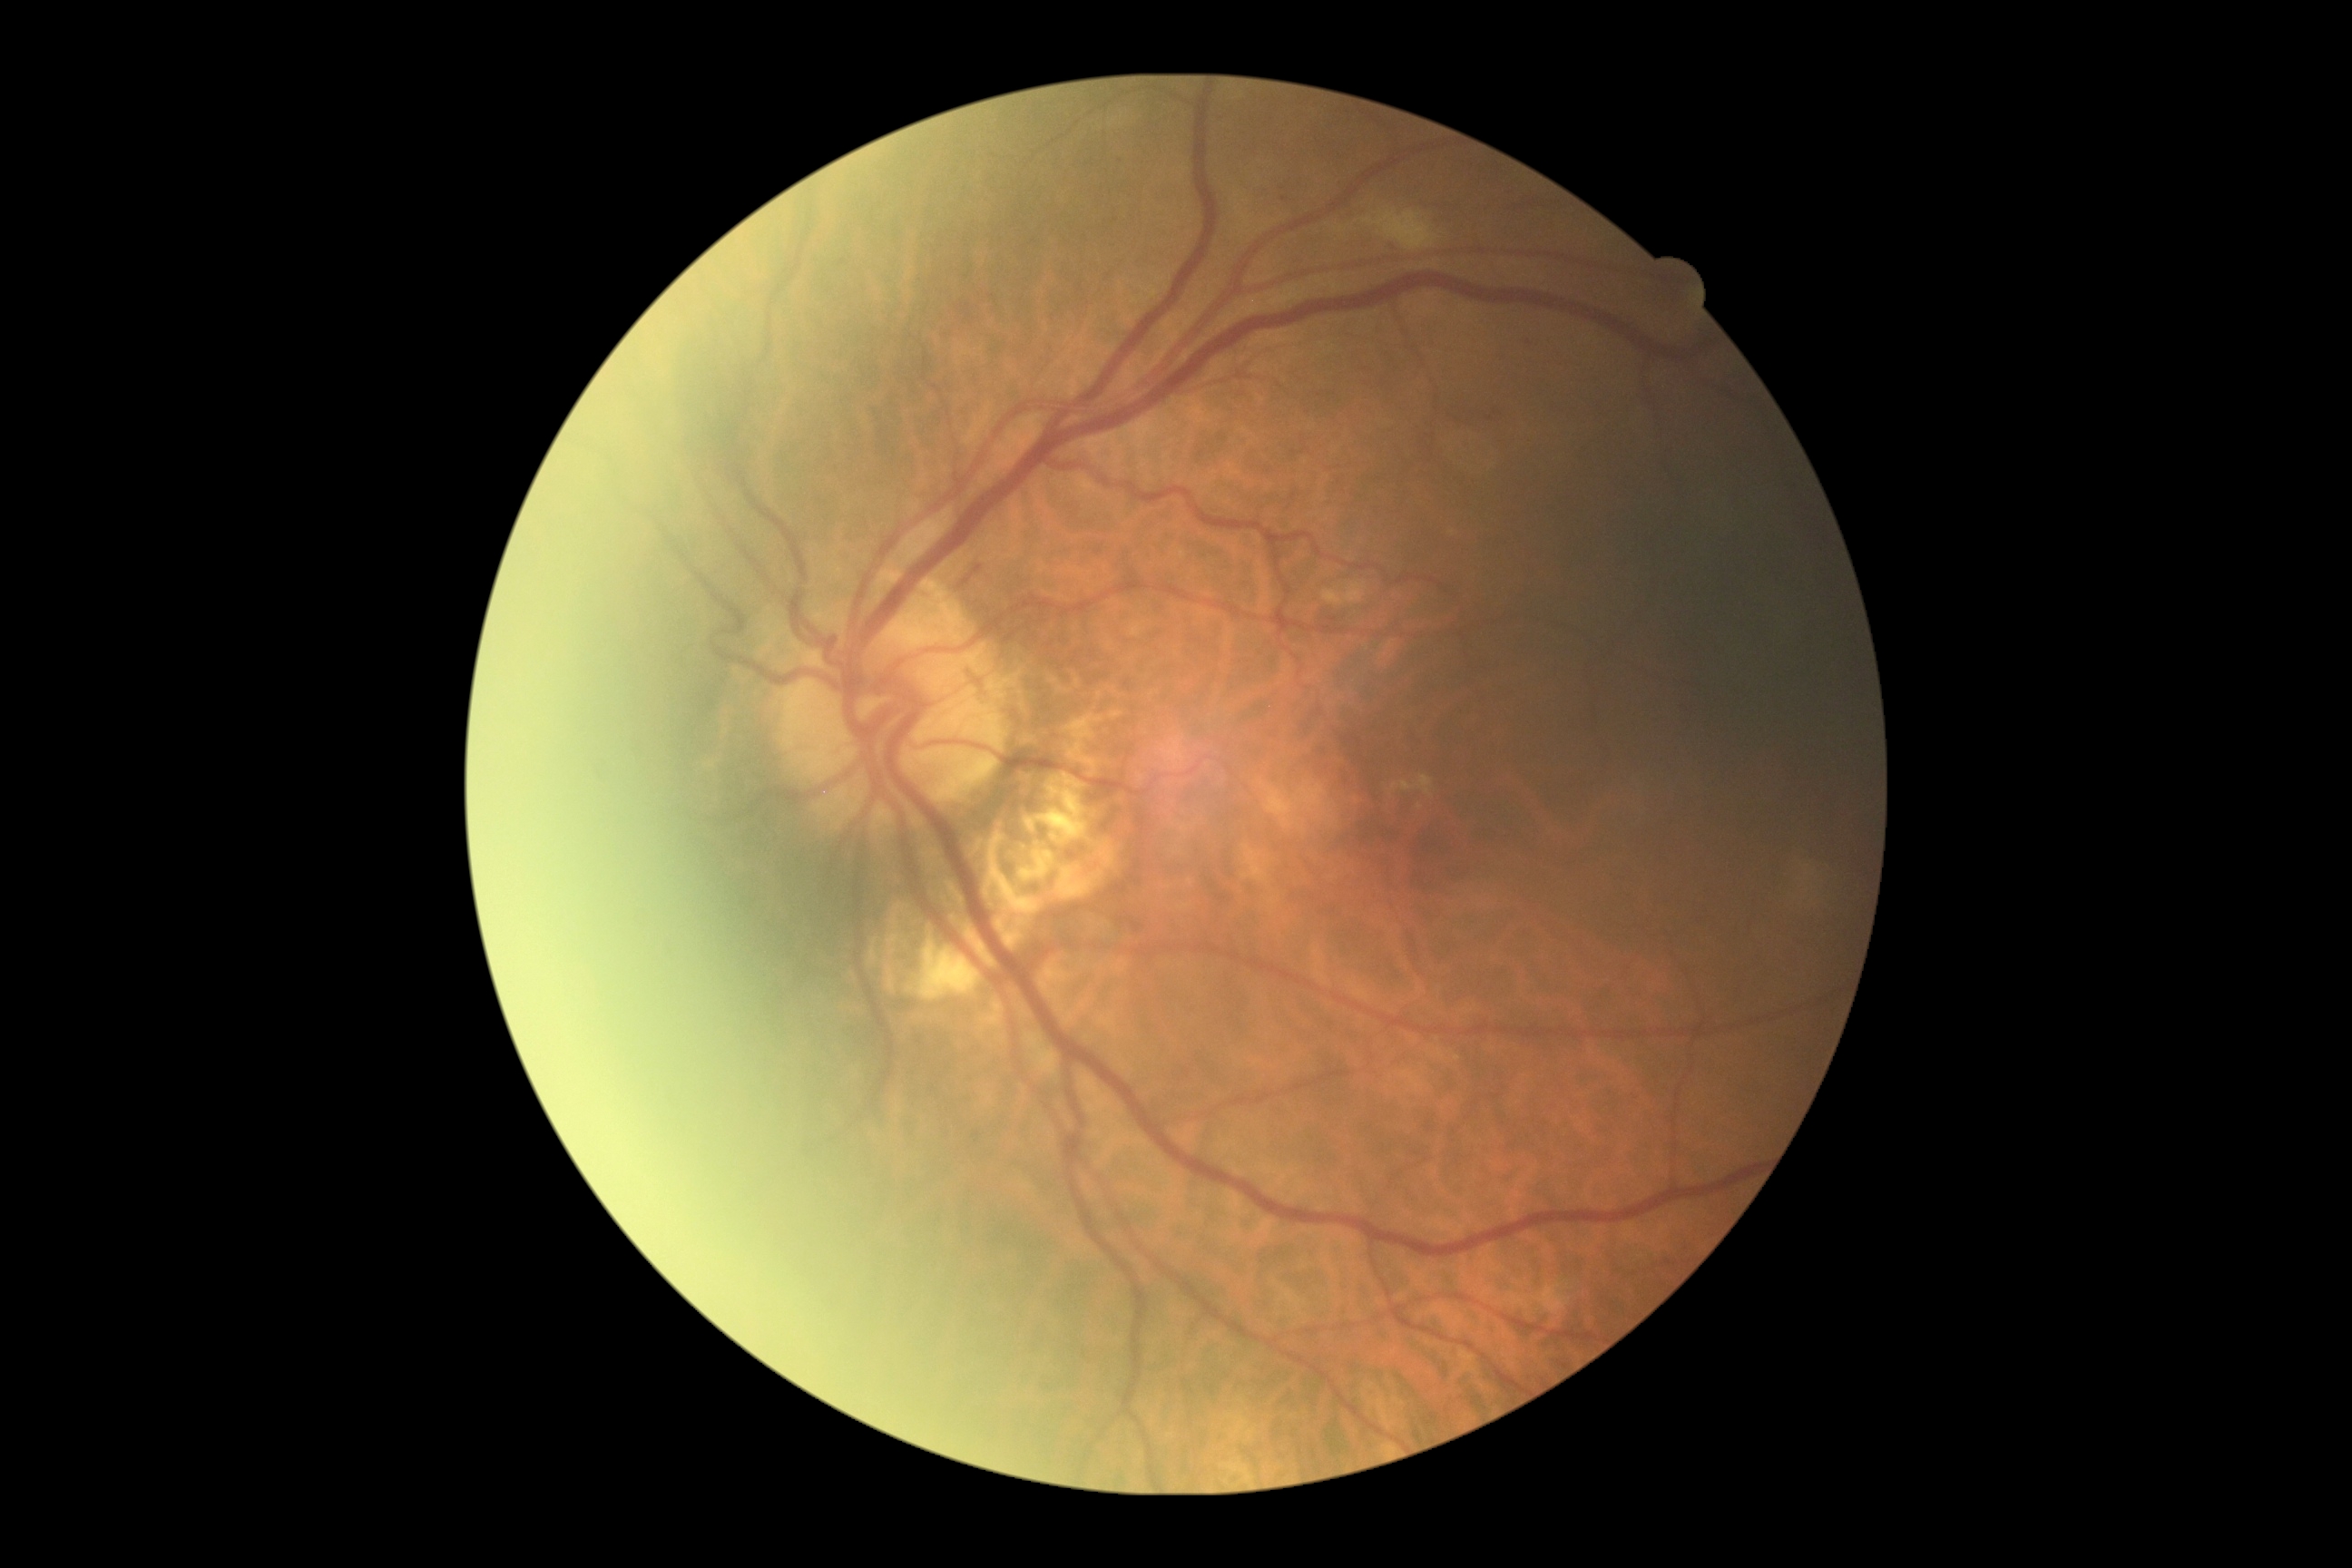
Retinopathy: moderate NPDR (grade 2).